Nonmydriatic fundus photograph · NIDEK AFC-230
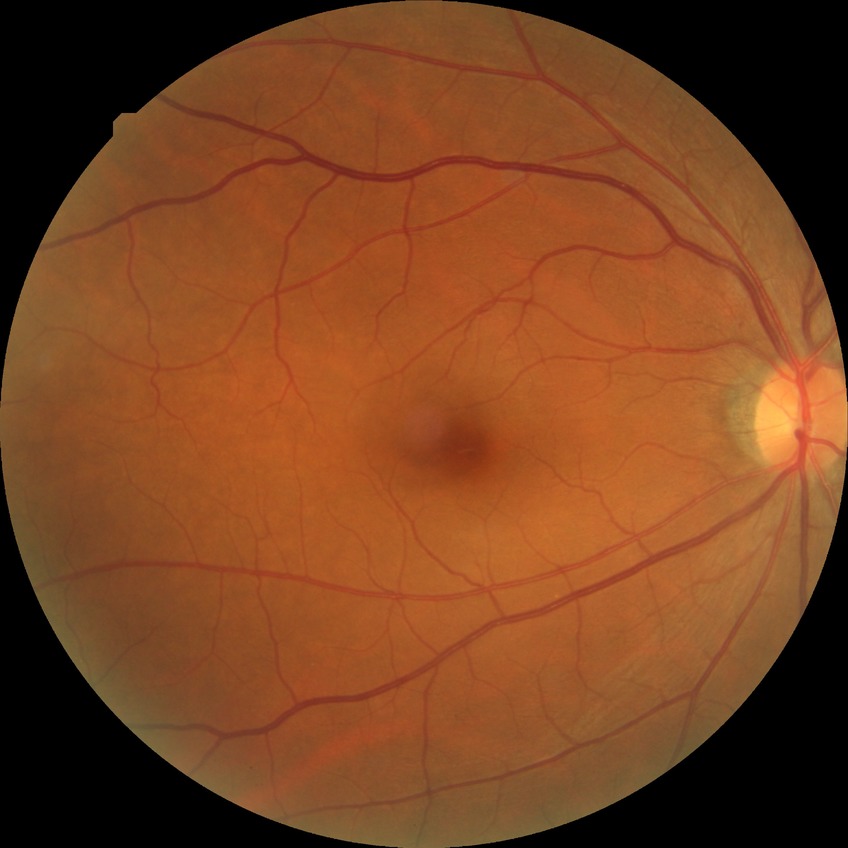
Davis grade=NDR; DR impression=no DR findings.